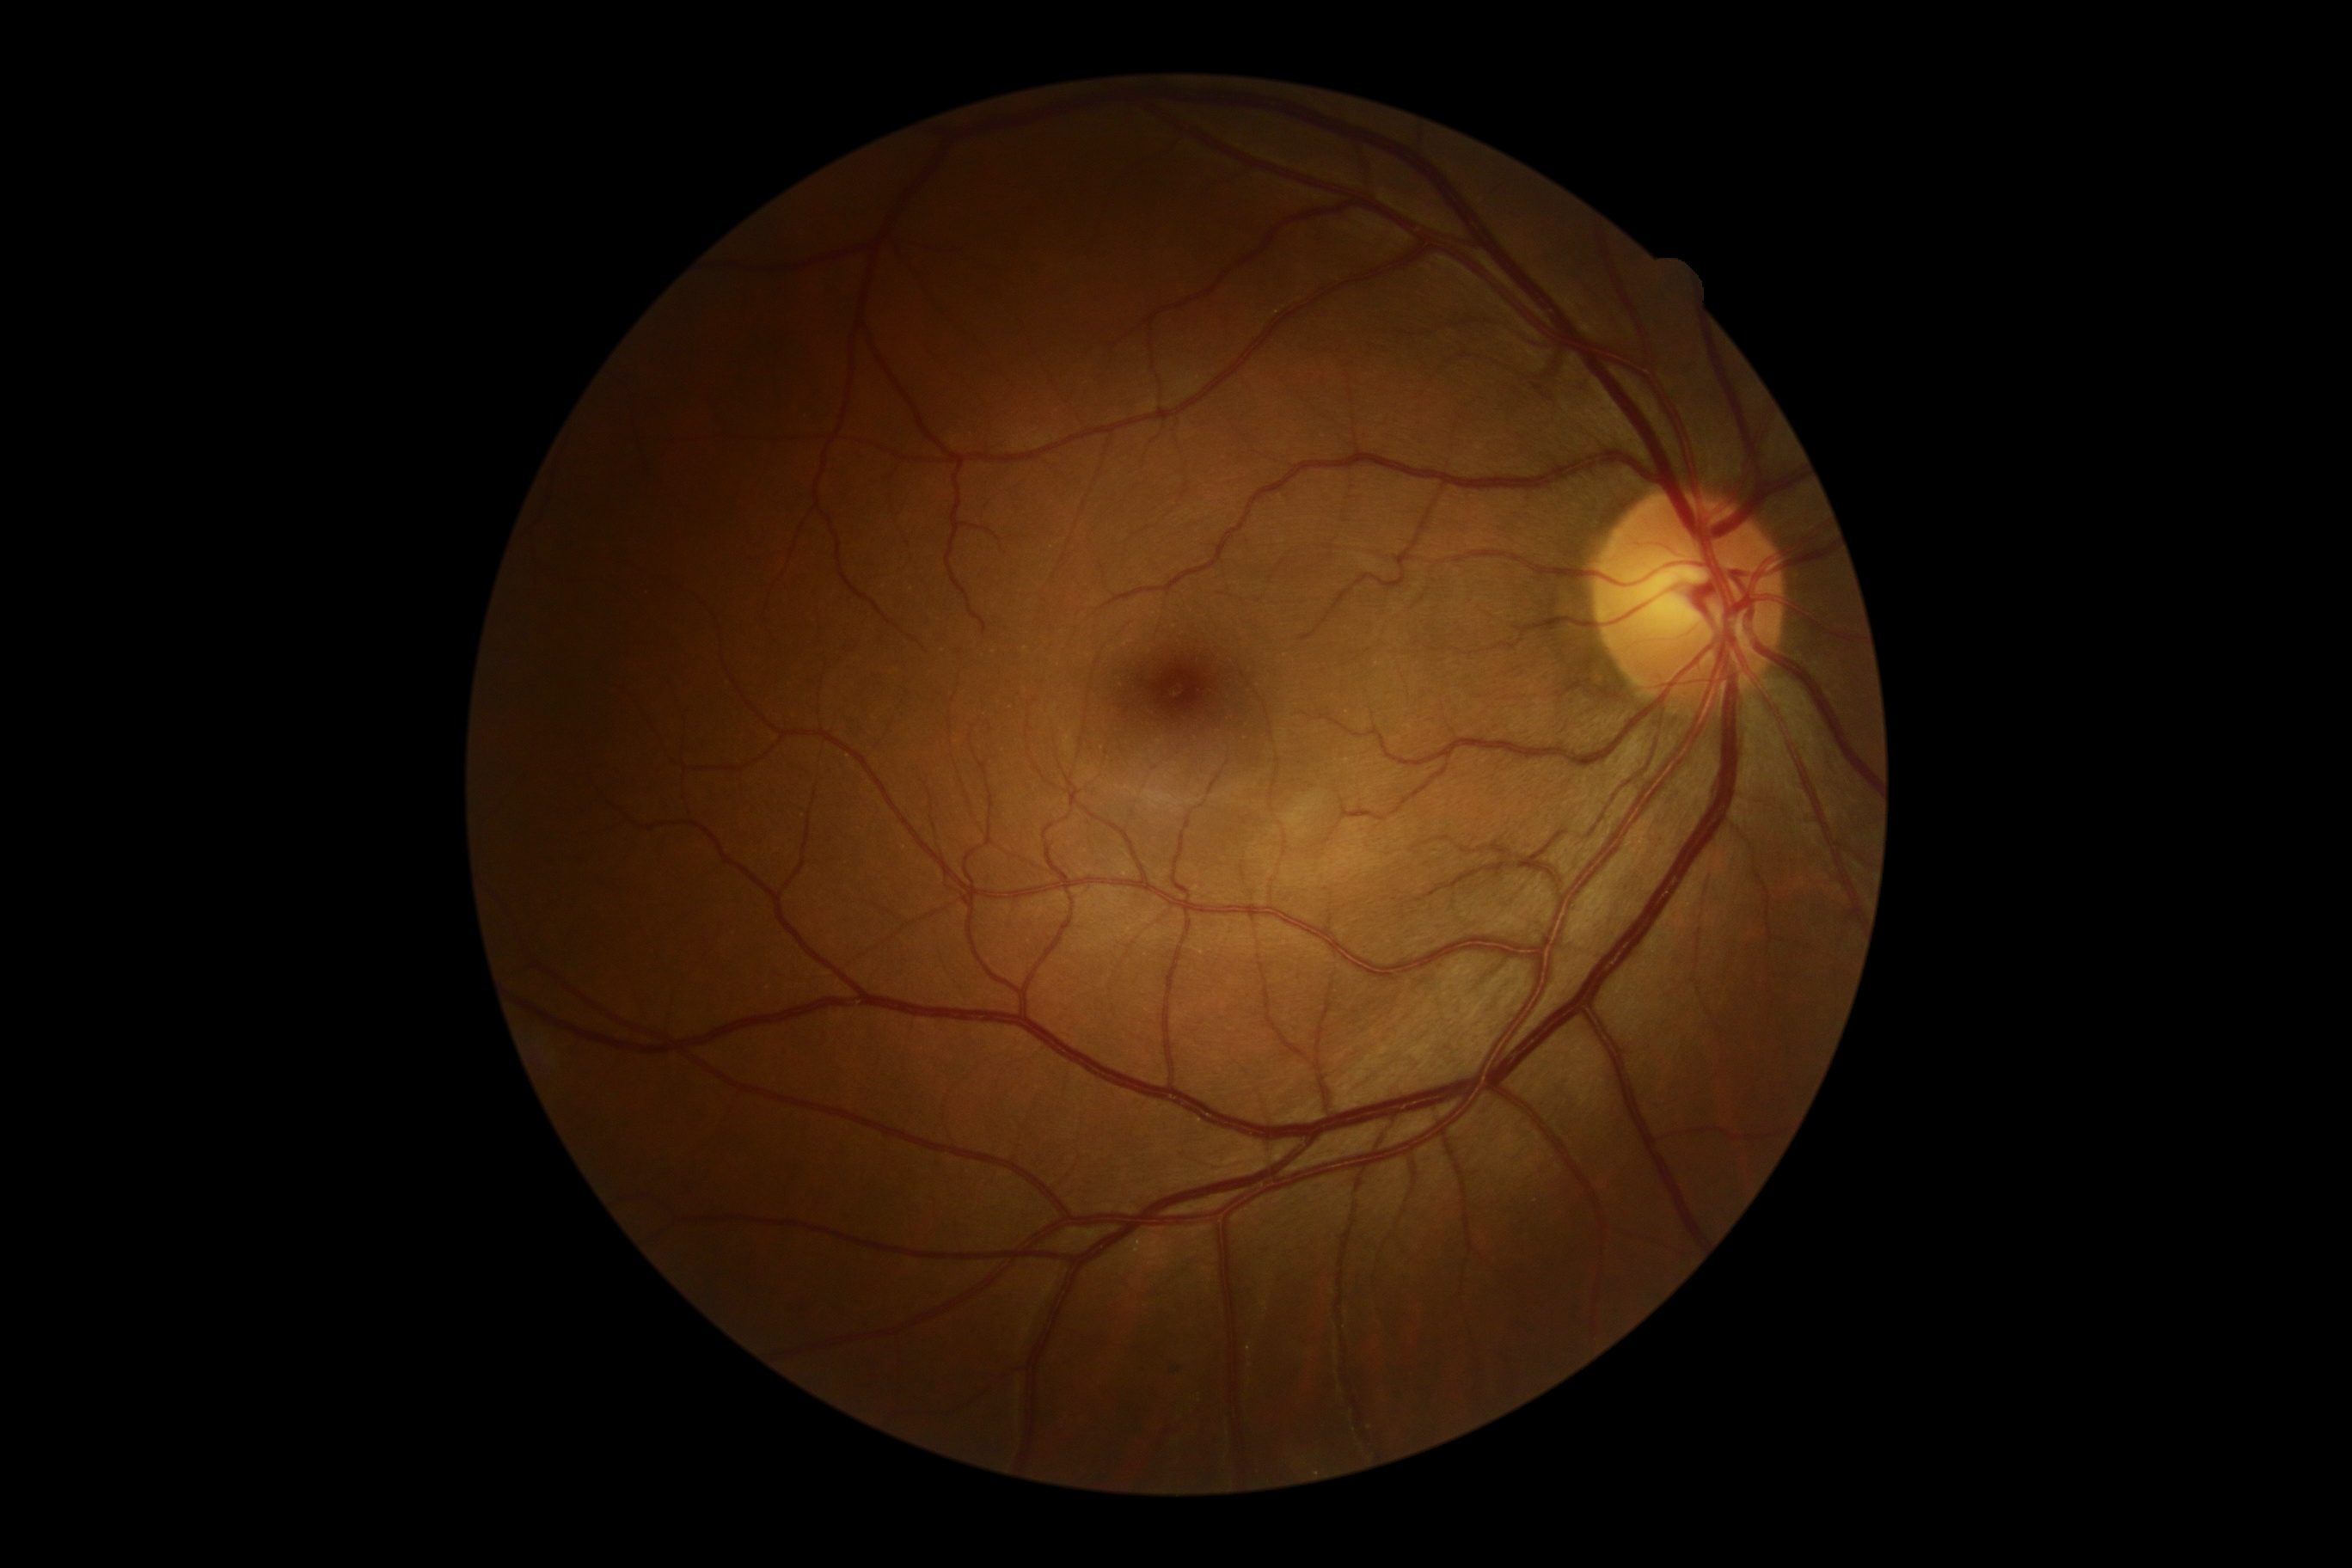 Diabetic retinopathy (DR): no apparent retinopathy (grade 0).